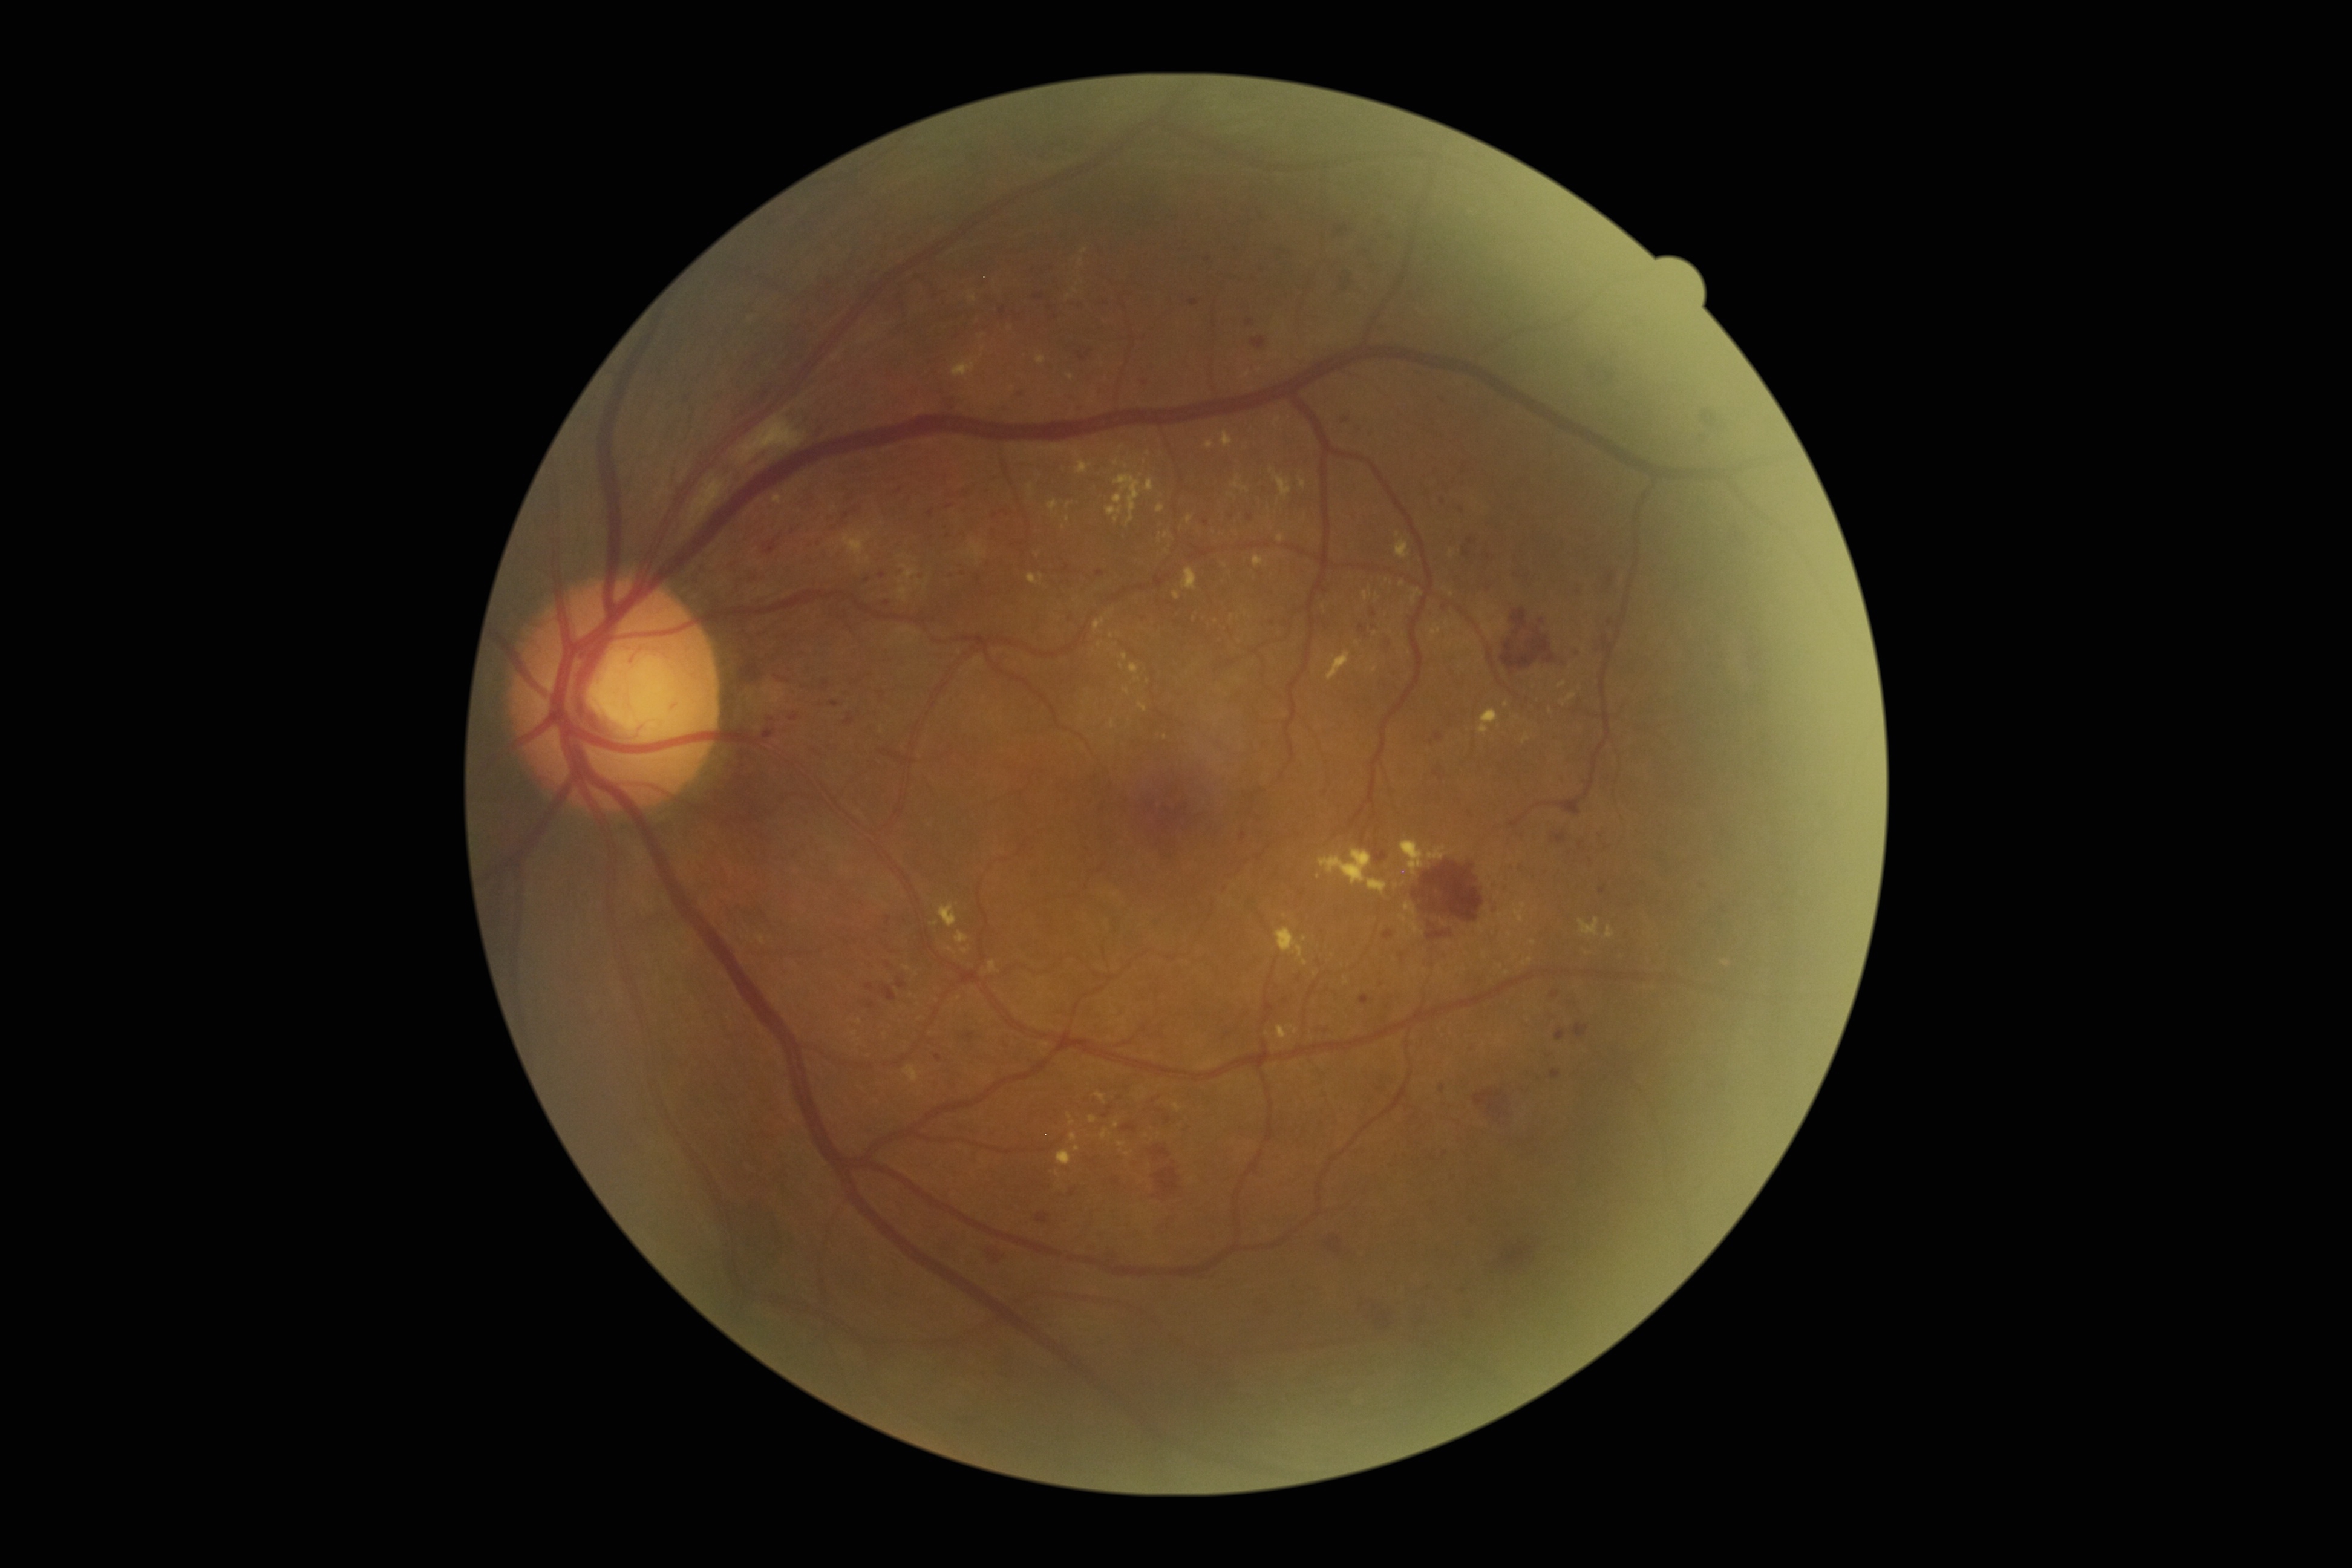

Diabetic retinopathy (DR): grade 3 (severe NPDR).